45° field of view, 2352x1568, color fundus photograph:
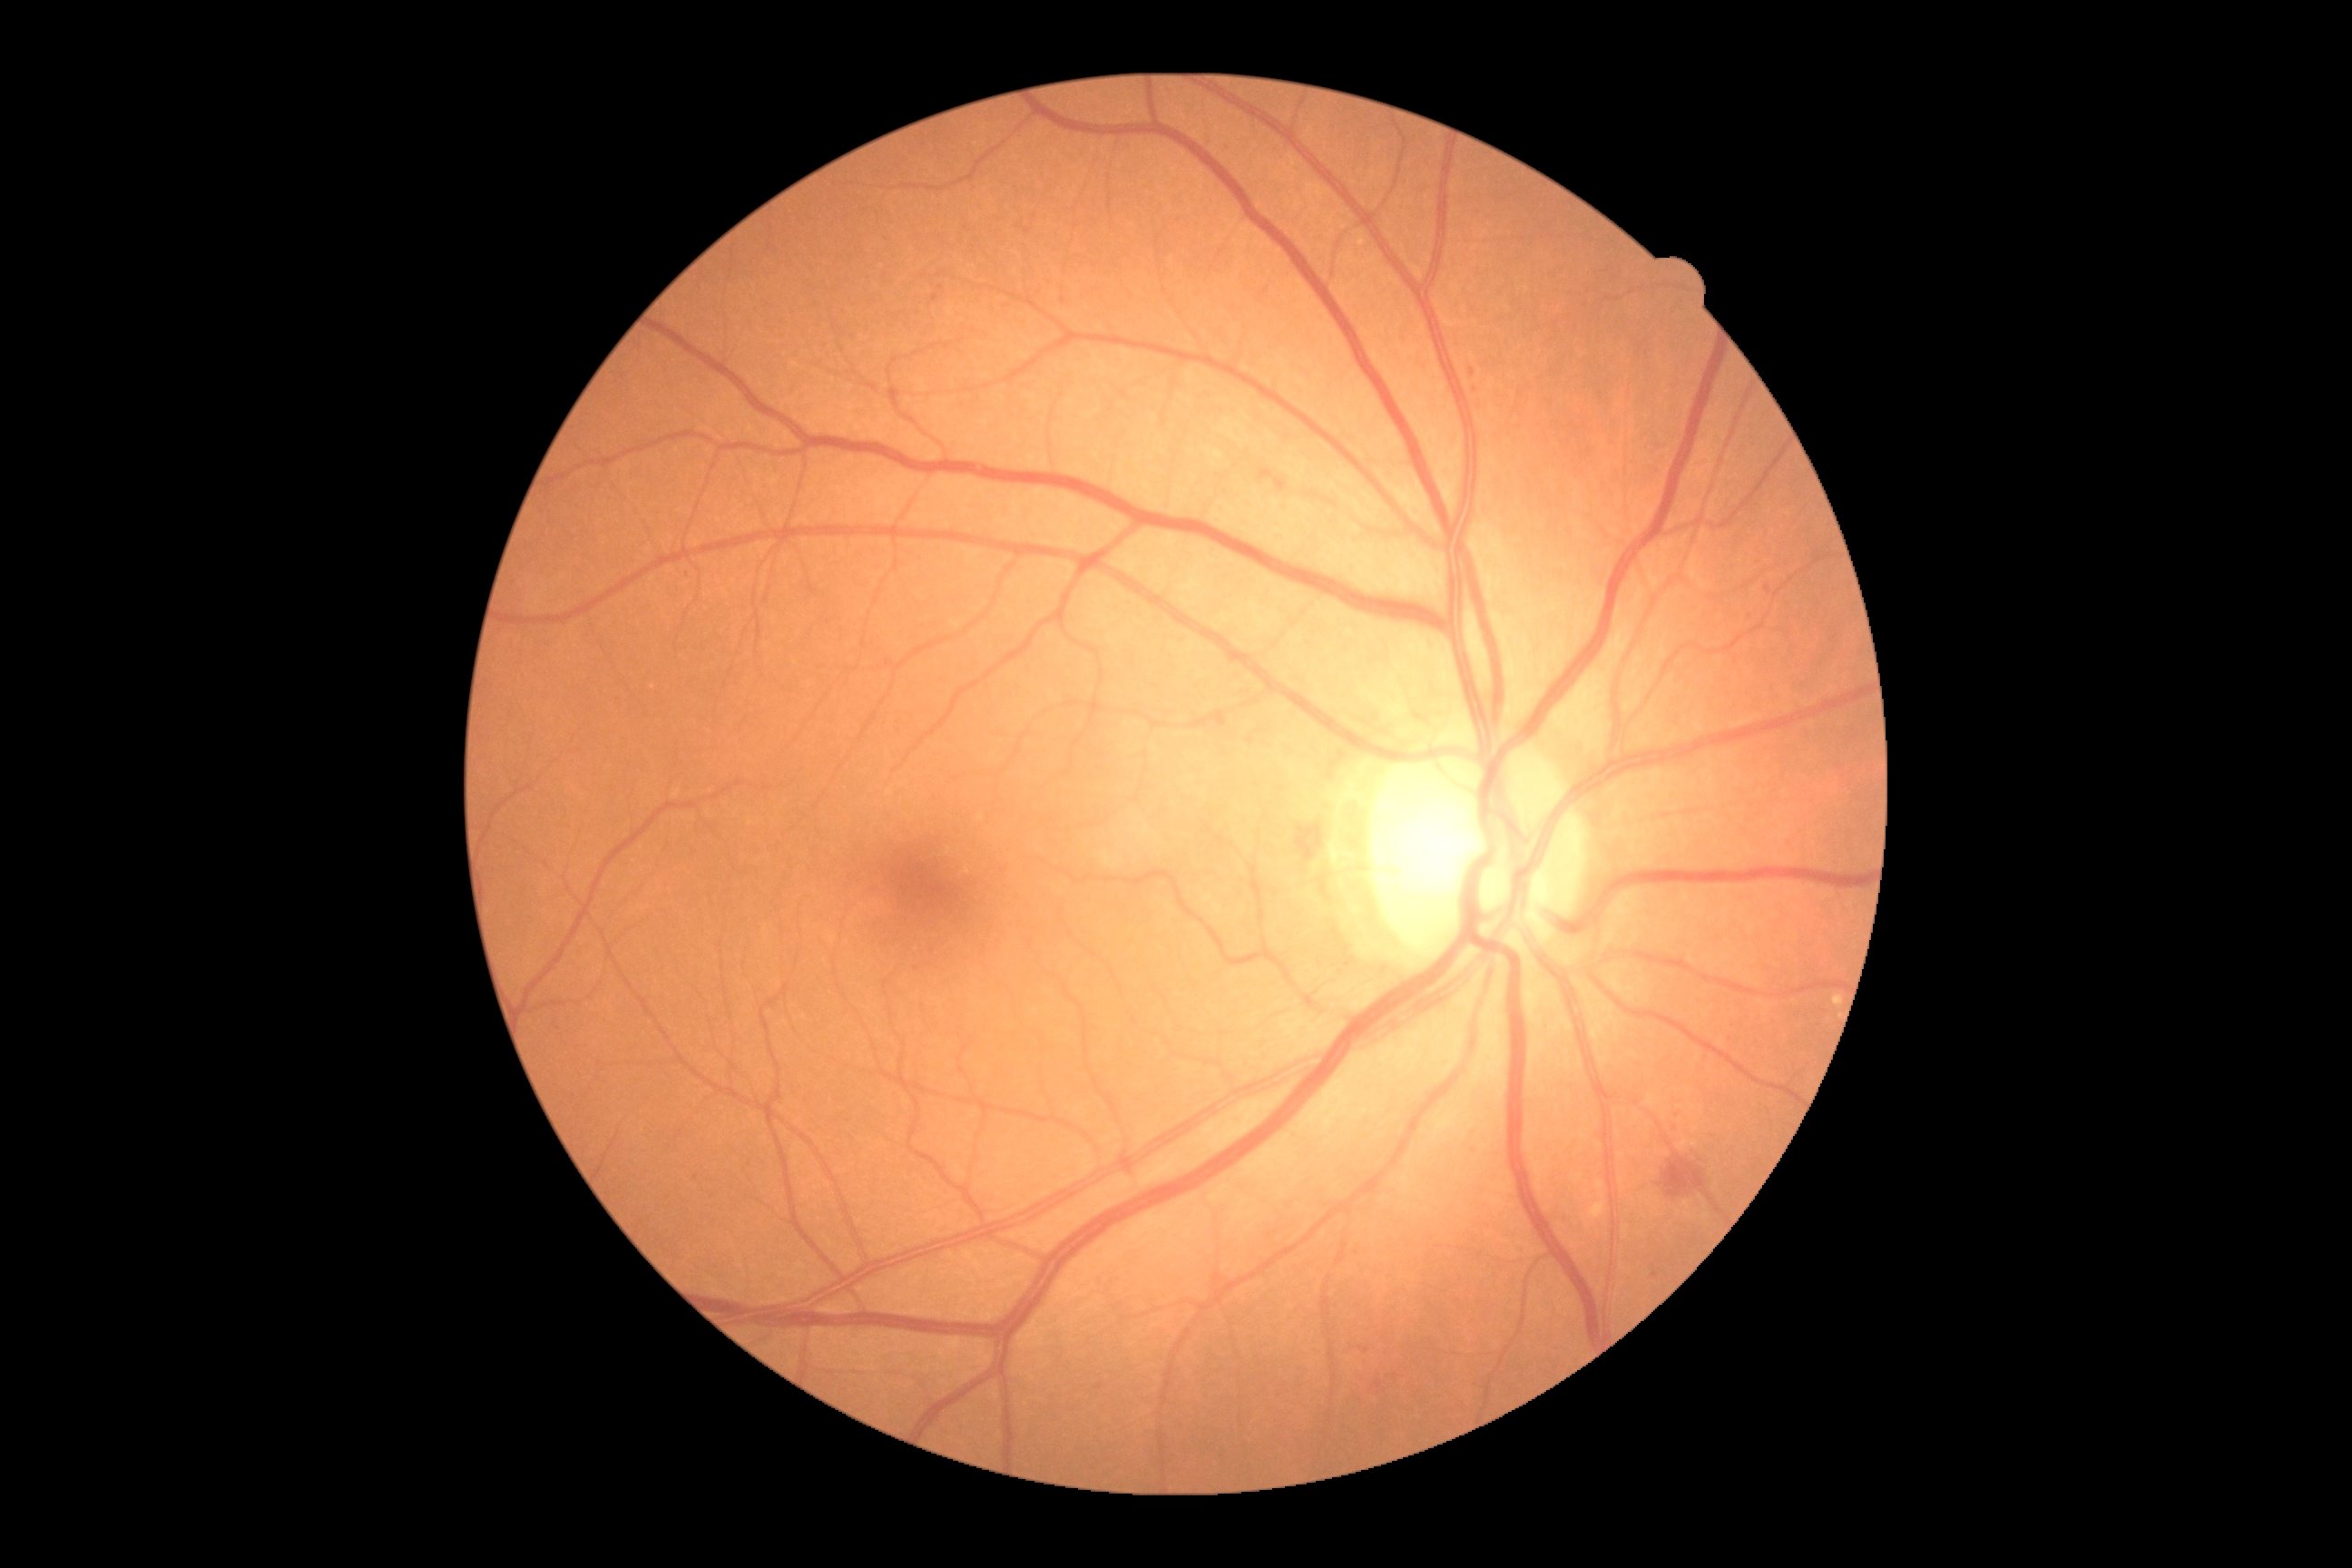 diabetic retinopathy severity = grade 2 (moderate NPDR).